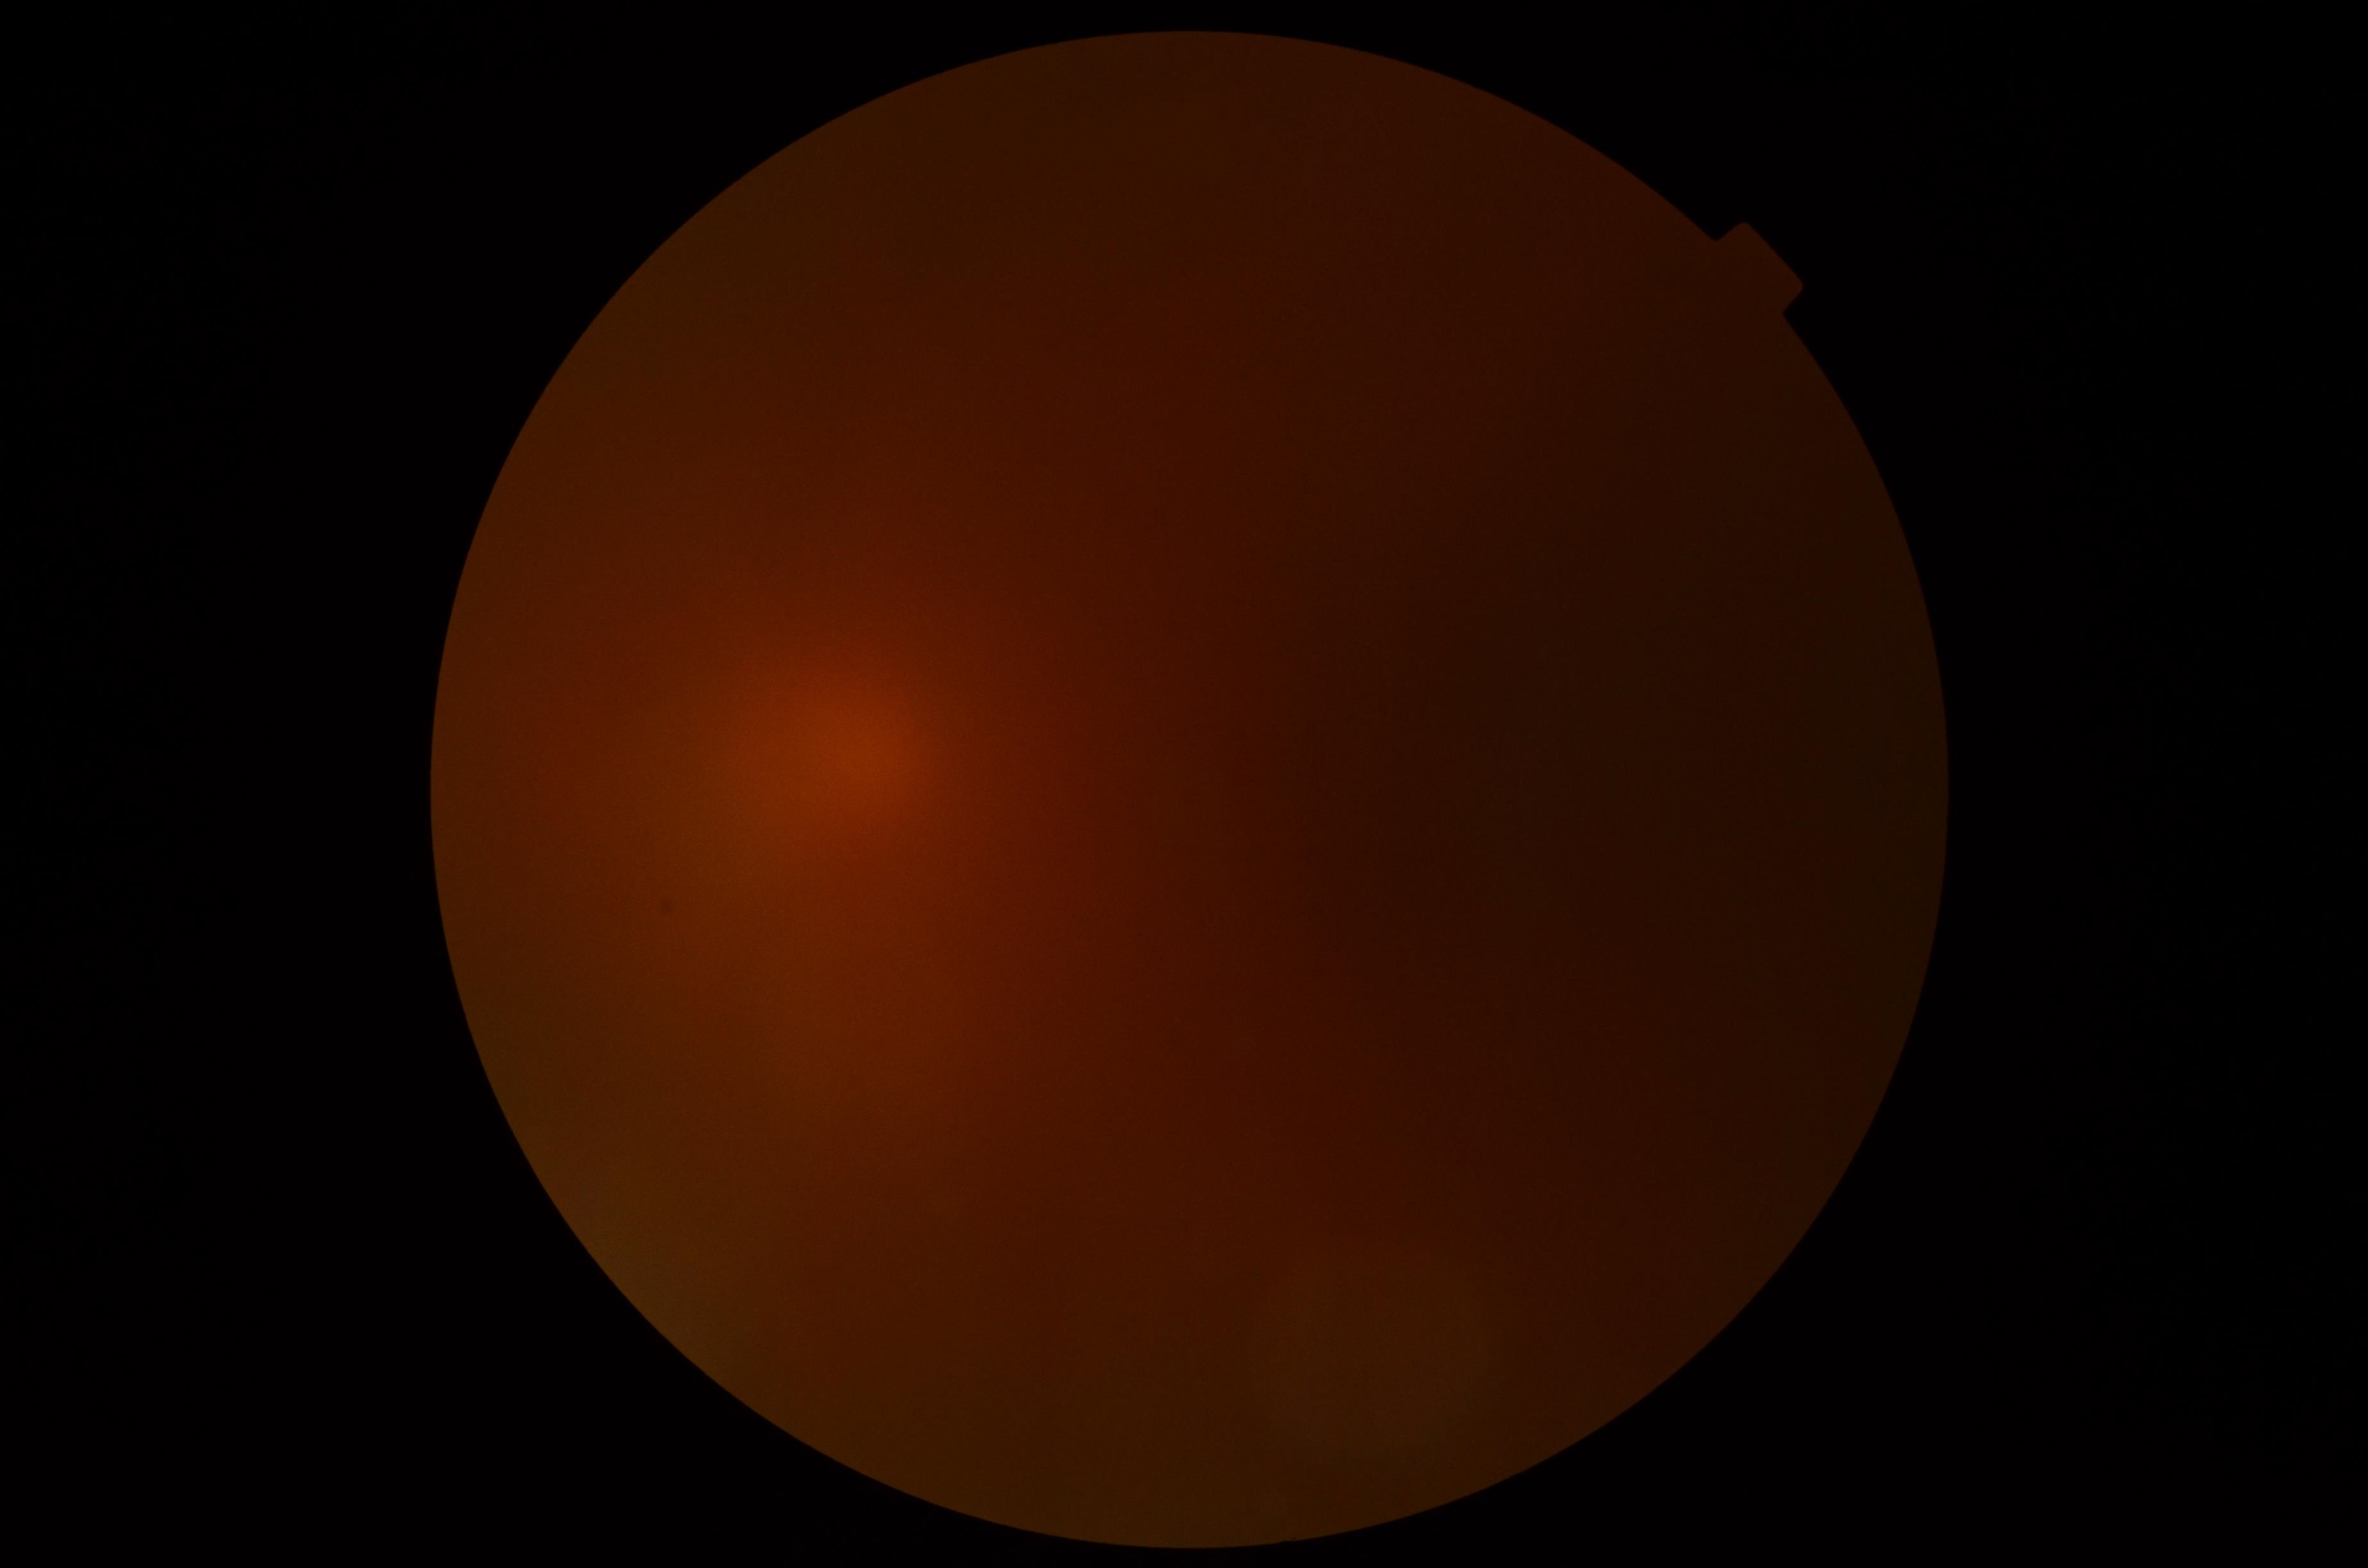
Annotations:
– image quality — insufficient
– diabetic retinopathy severity — ungradable due to poor image quality